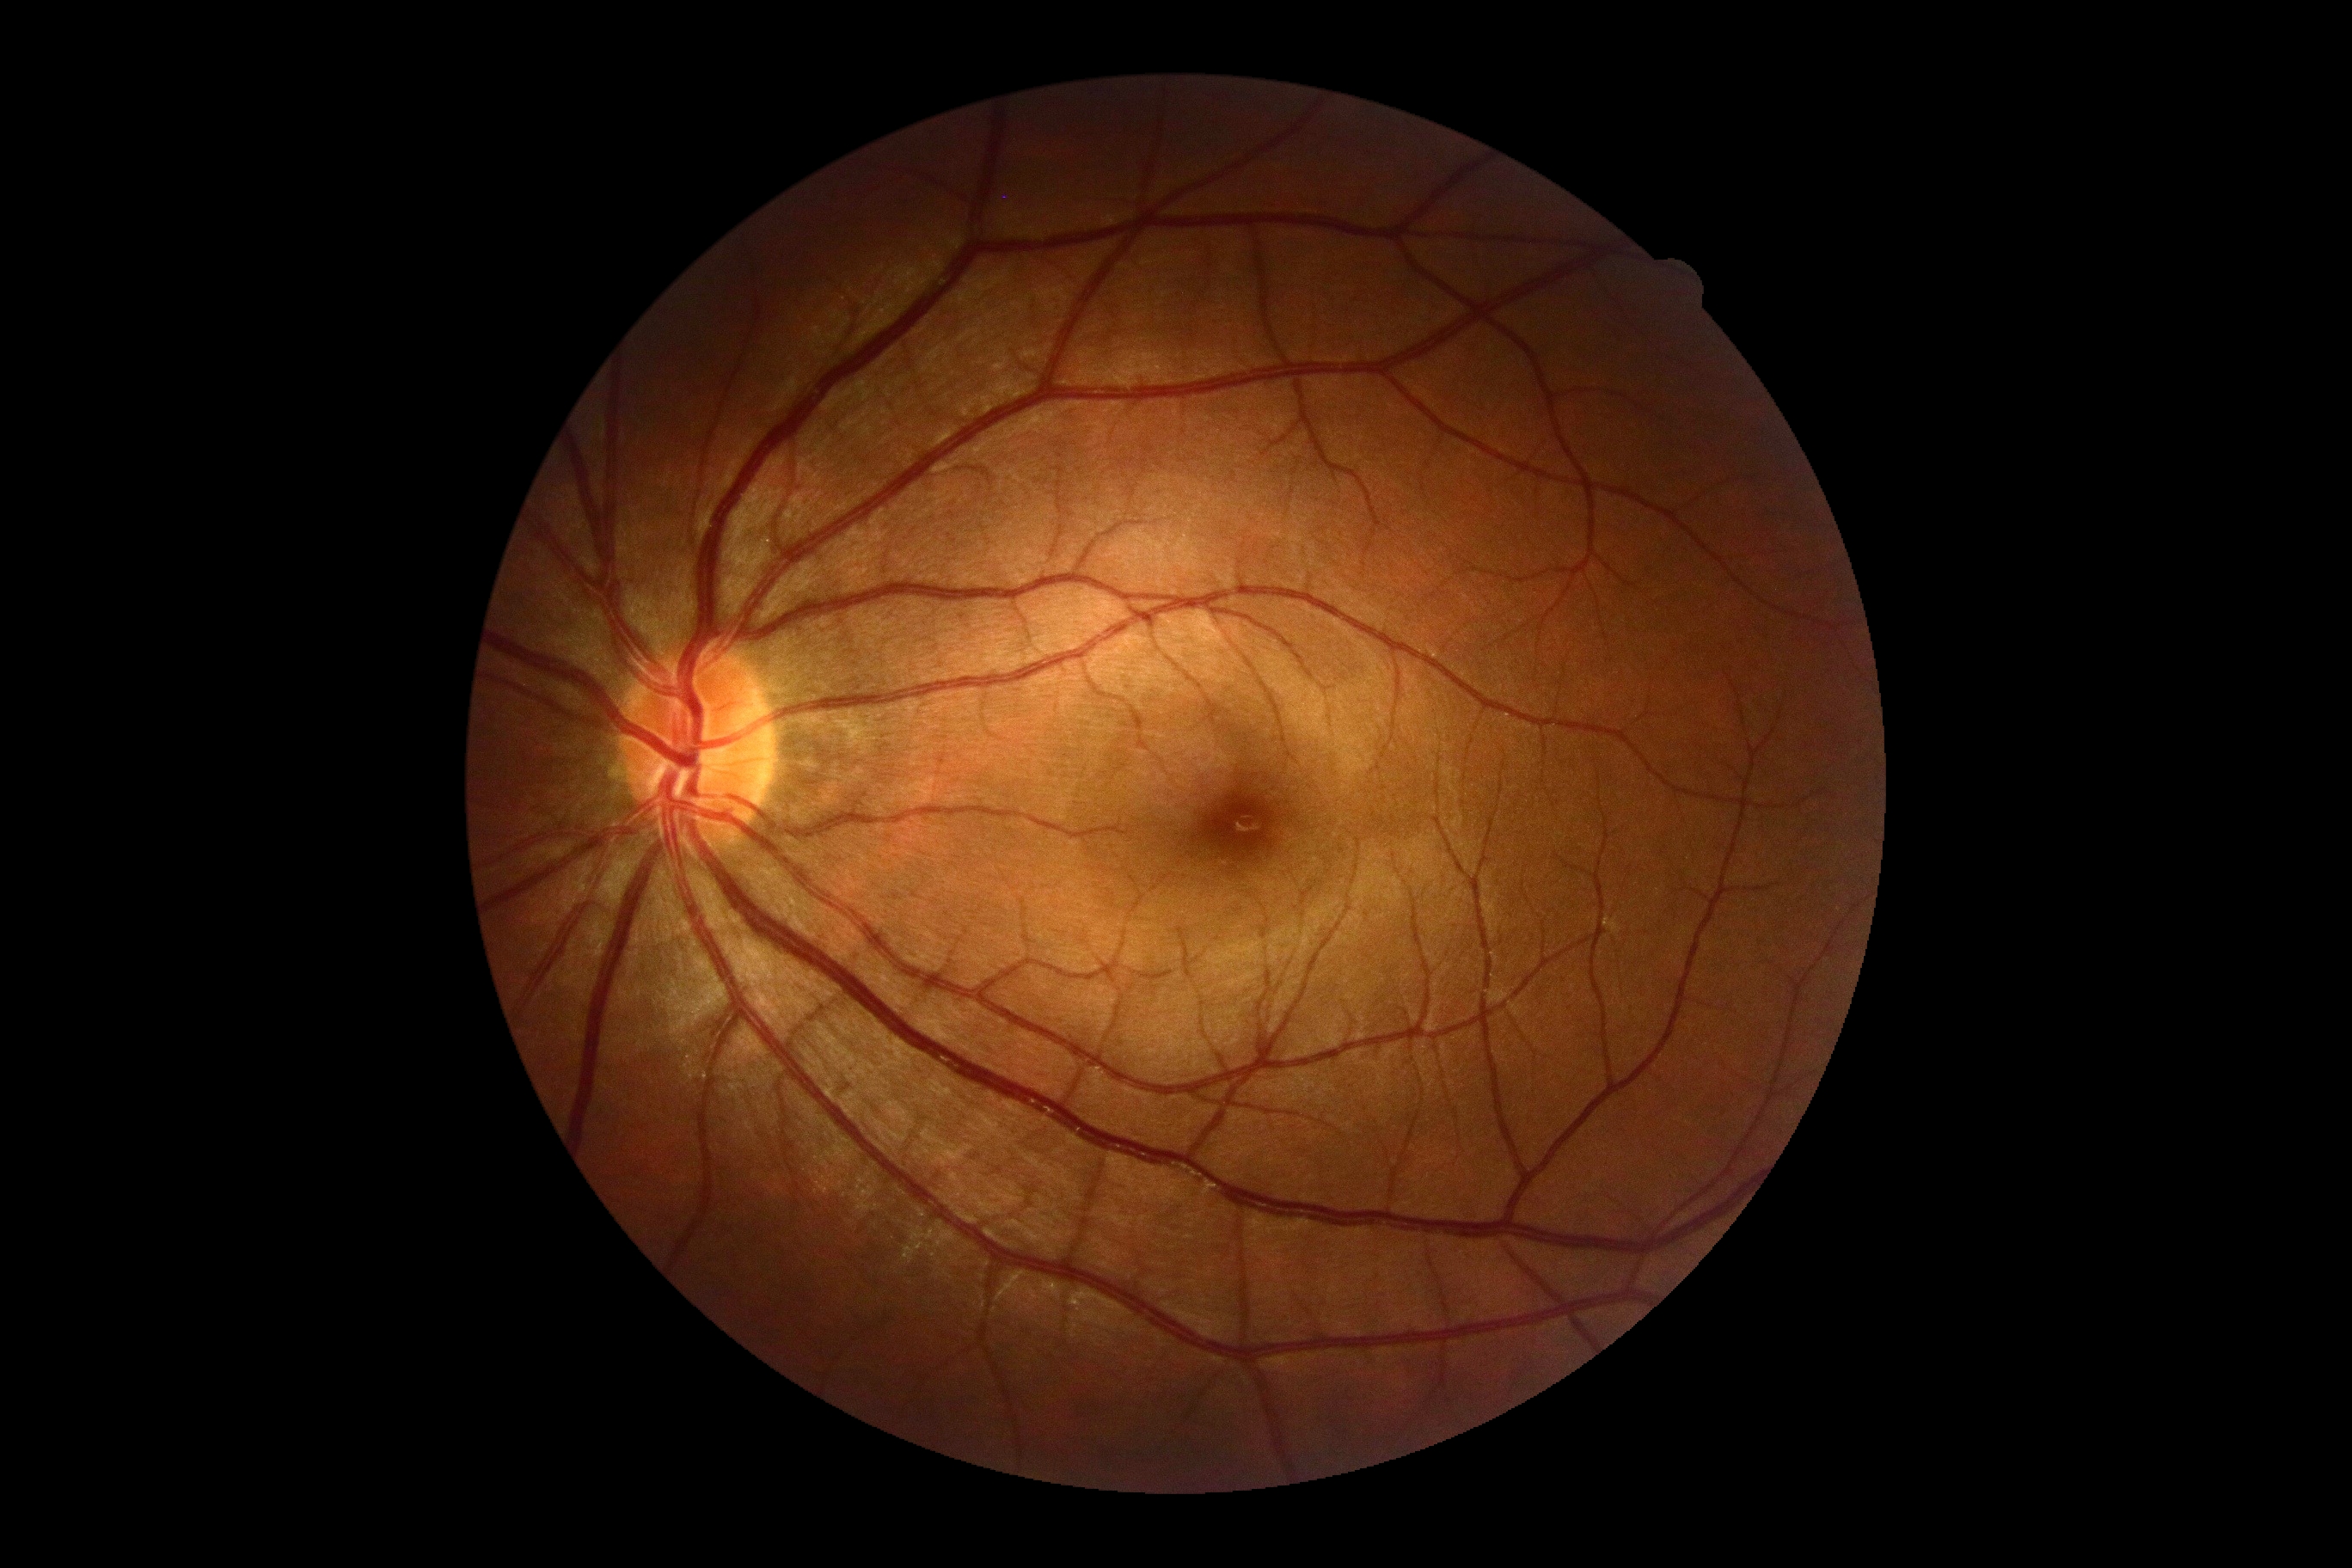

* diabetic retinopathy severity — grade 0 (no apparent retinopathy) — no visible signs of diabetic retinopathy